ONH-centered crop from a color fundus image:
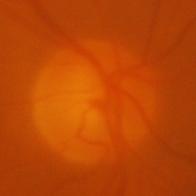

Findings consistent with evidence of glaucoma.